Pediatric wide-field fundus photograph. 130° field of view (Clarity RetCam 3) — 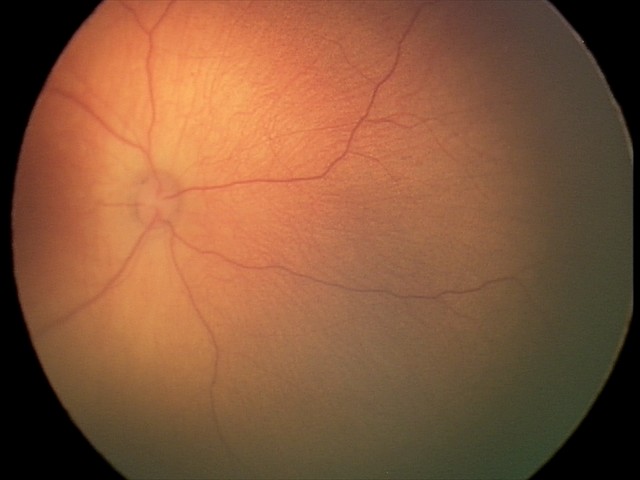

No retinal pathology identified on screening.